848x848. Nonmydriatic fundus photograph:
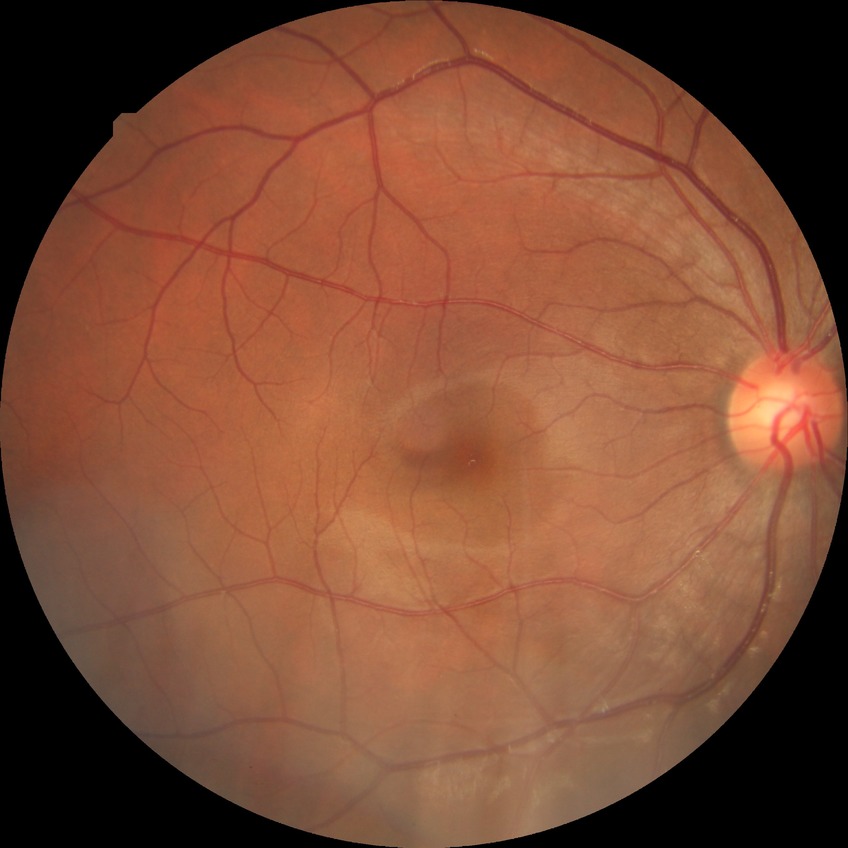 Retinopathy stage: no diabetic retinopathy.